Color fundus image; 45° field of view — 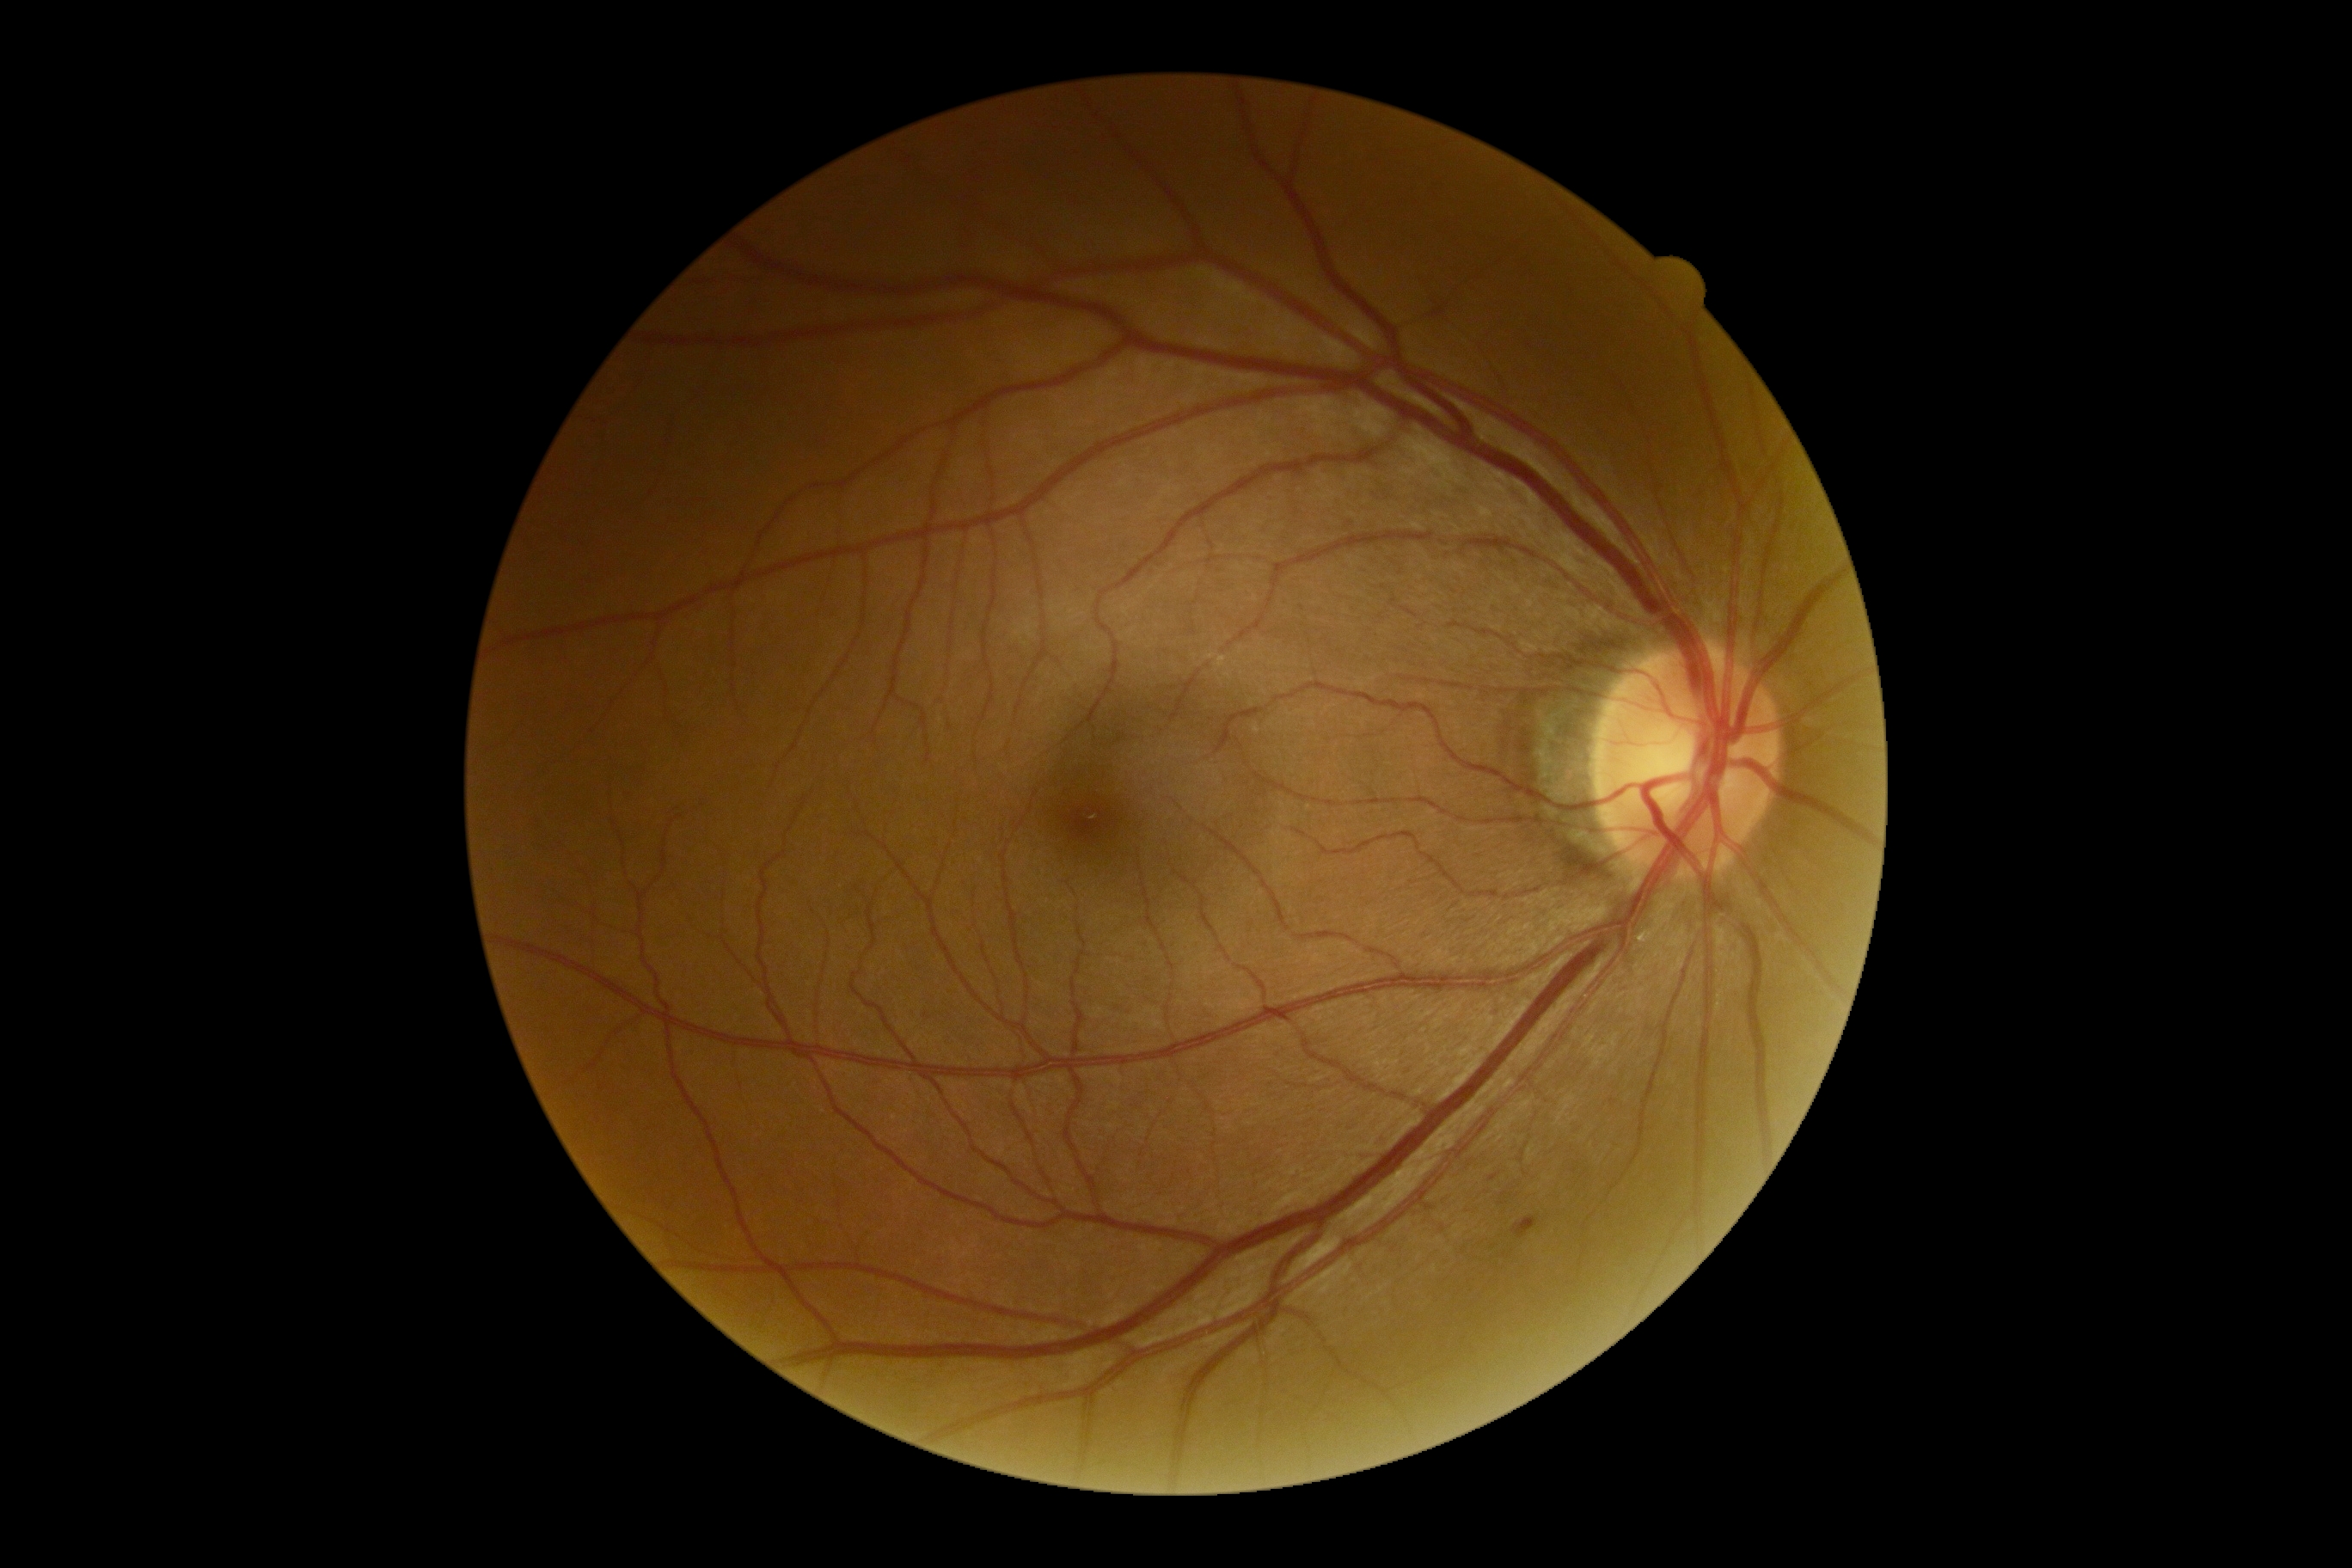 DR grade: 2 (moderate NPDR).